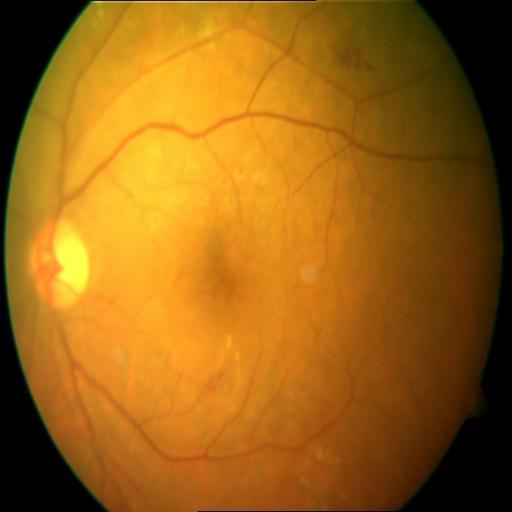

Retinal fundus photograph demonstrating cystoid macular edema.